Infant wide-field fundus photograph; 1240x1240px.
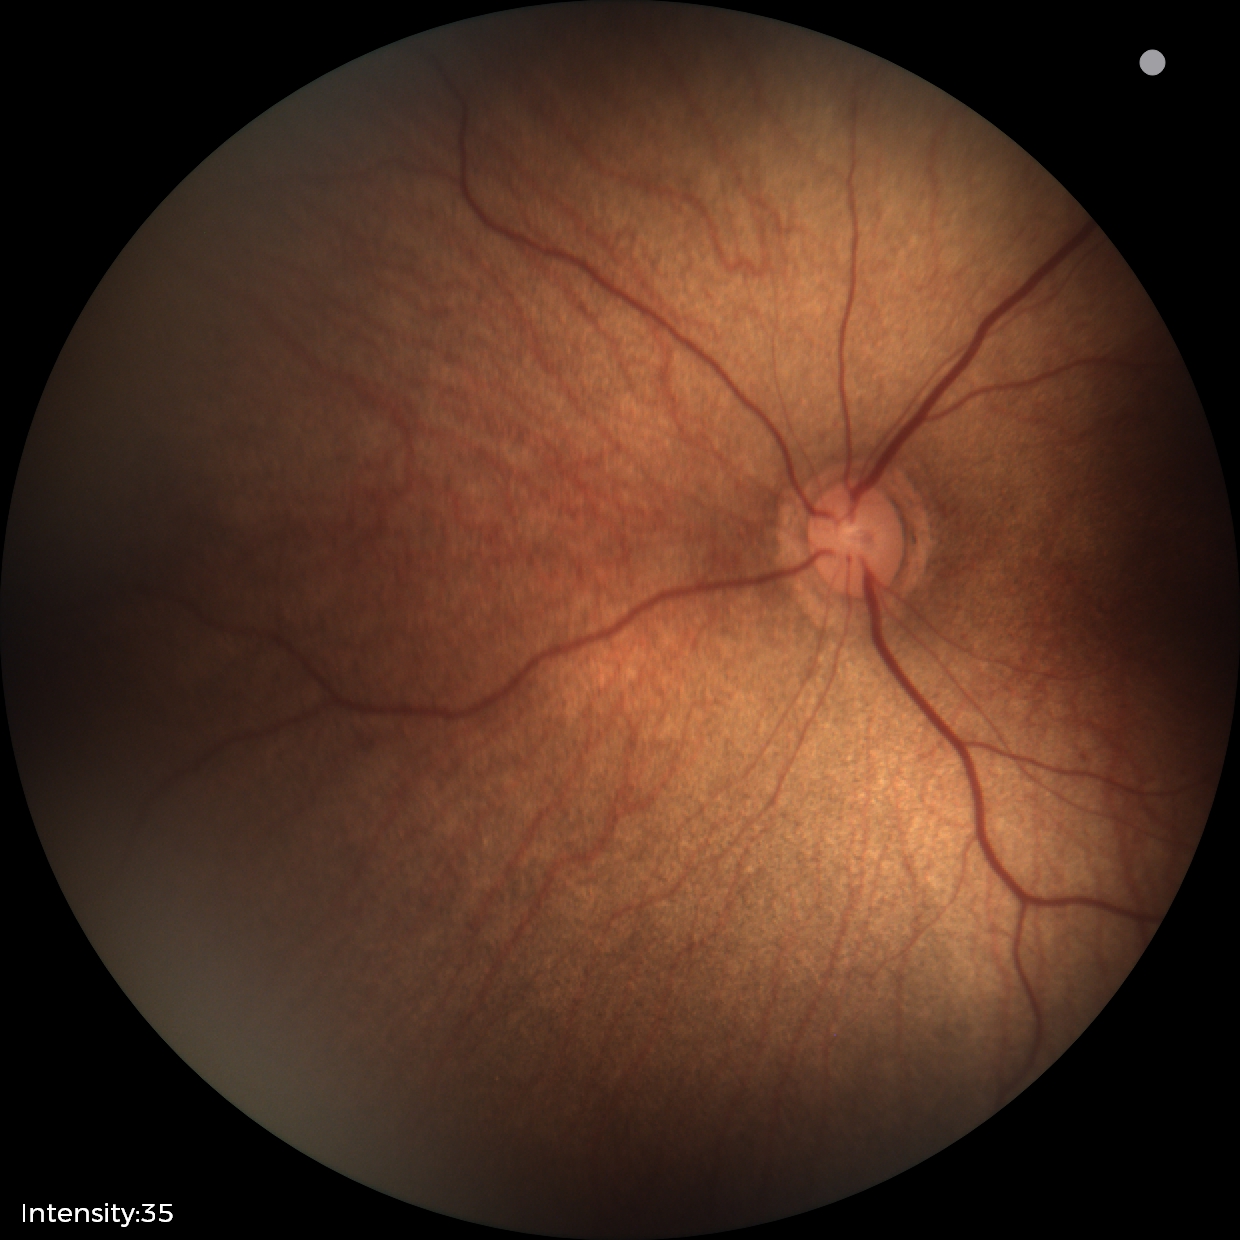
Examination with physiological retinal findings.